45° field of view. 848x848. Posterior pole photograph. Nonmydriatic fundus photograph. NIDEK AFC-230 fundus camera. Graded on the modified Davis scale:
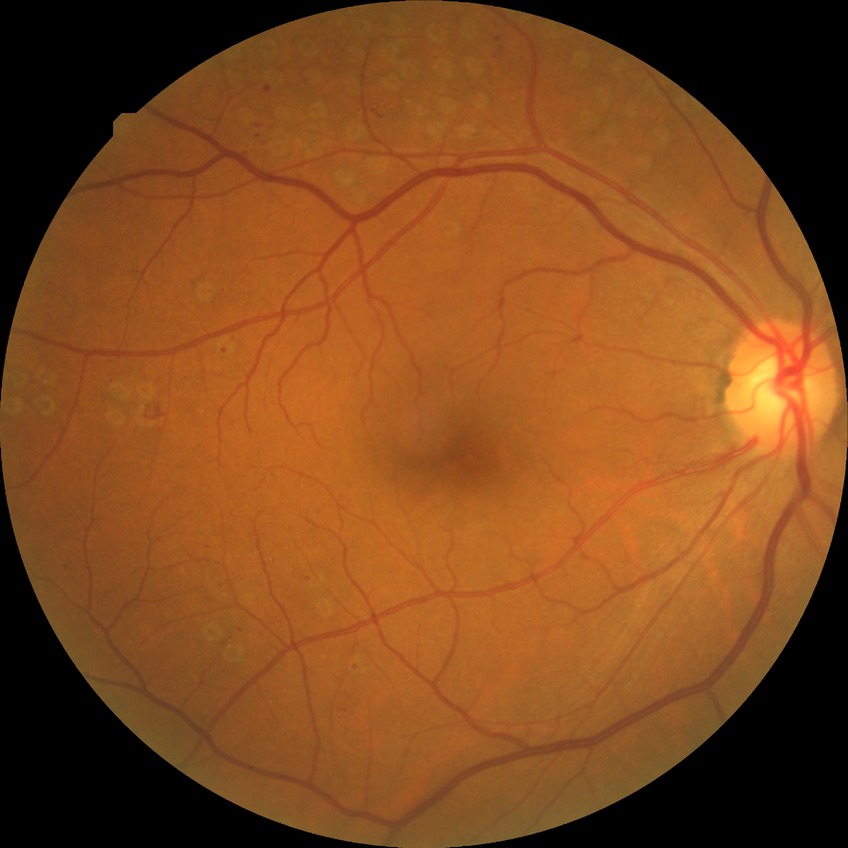 Diabetic retinopathy (DR): proliferative diabetic retinopathy (PDR).